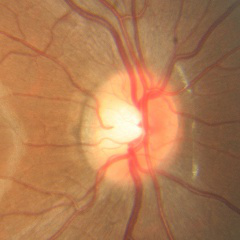
Optic disc appearance consistent with no evidence of glaucoma.